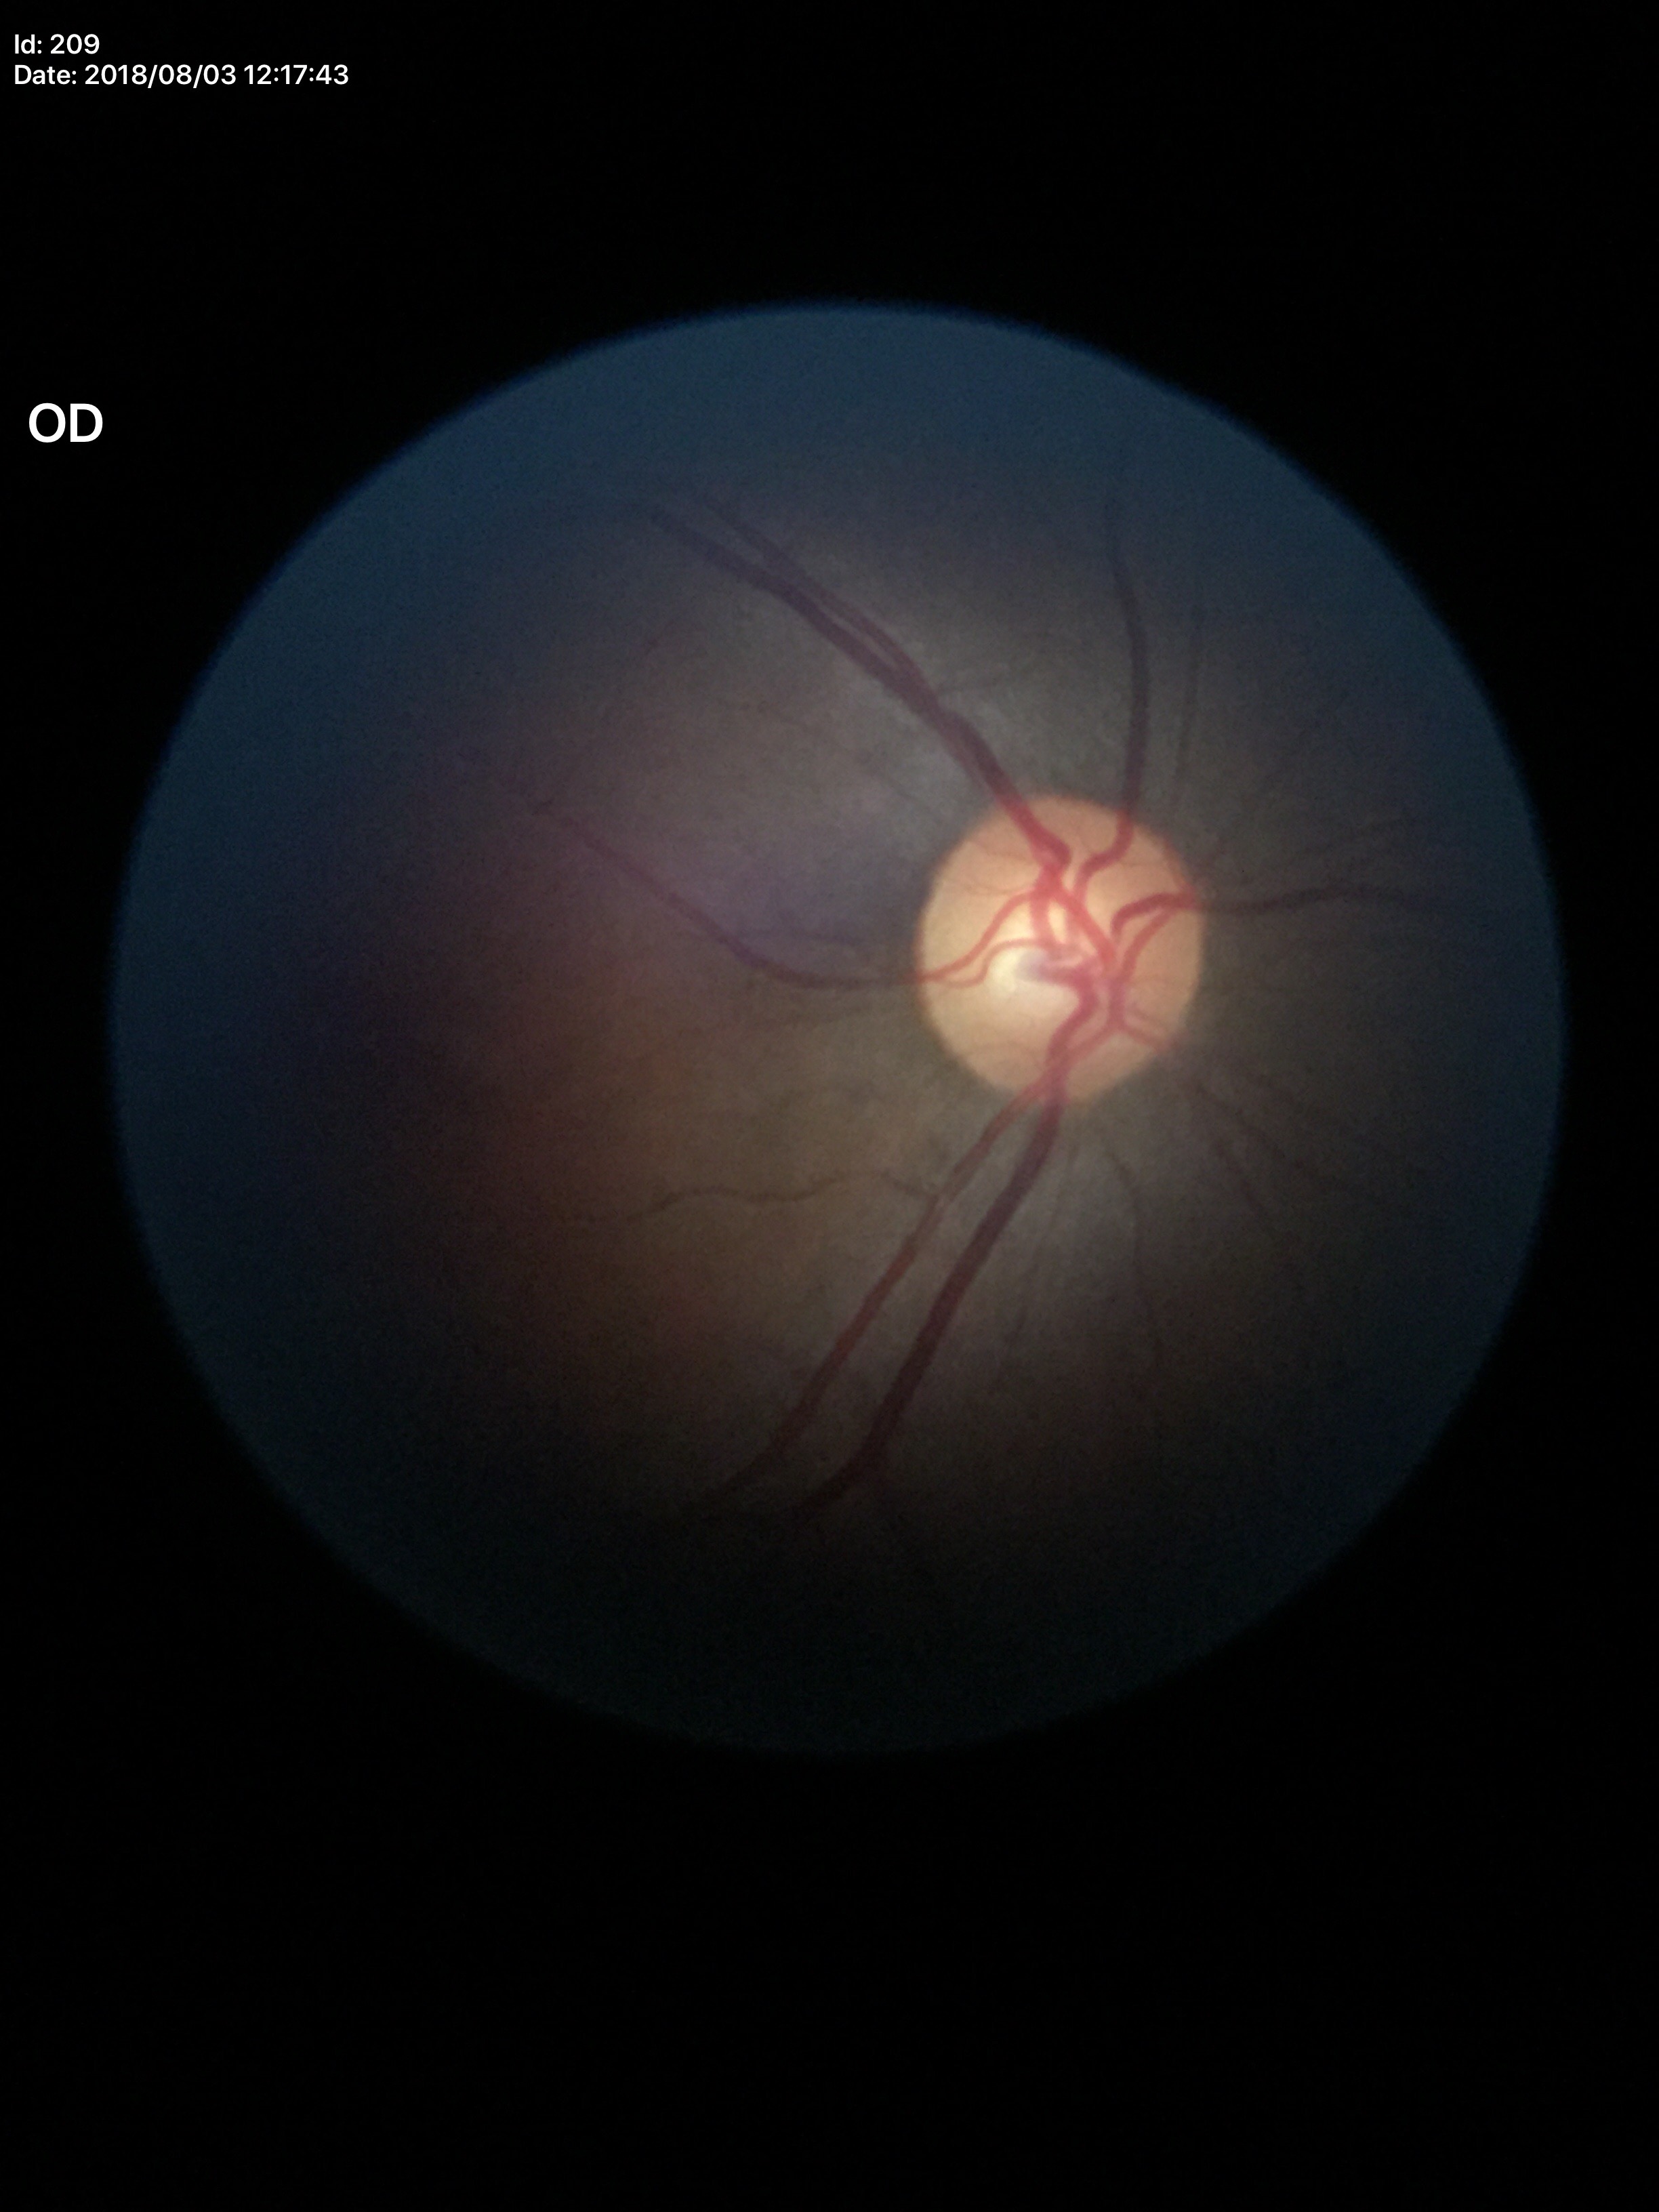

– Glaucoma impression — no suspicious findings (all 5 graders called normal)
– VCDR — 0.51
– HCDR — 0.48